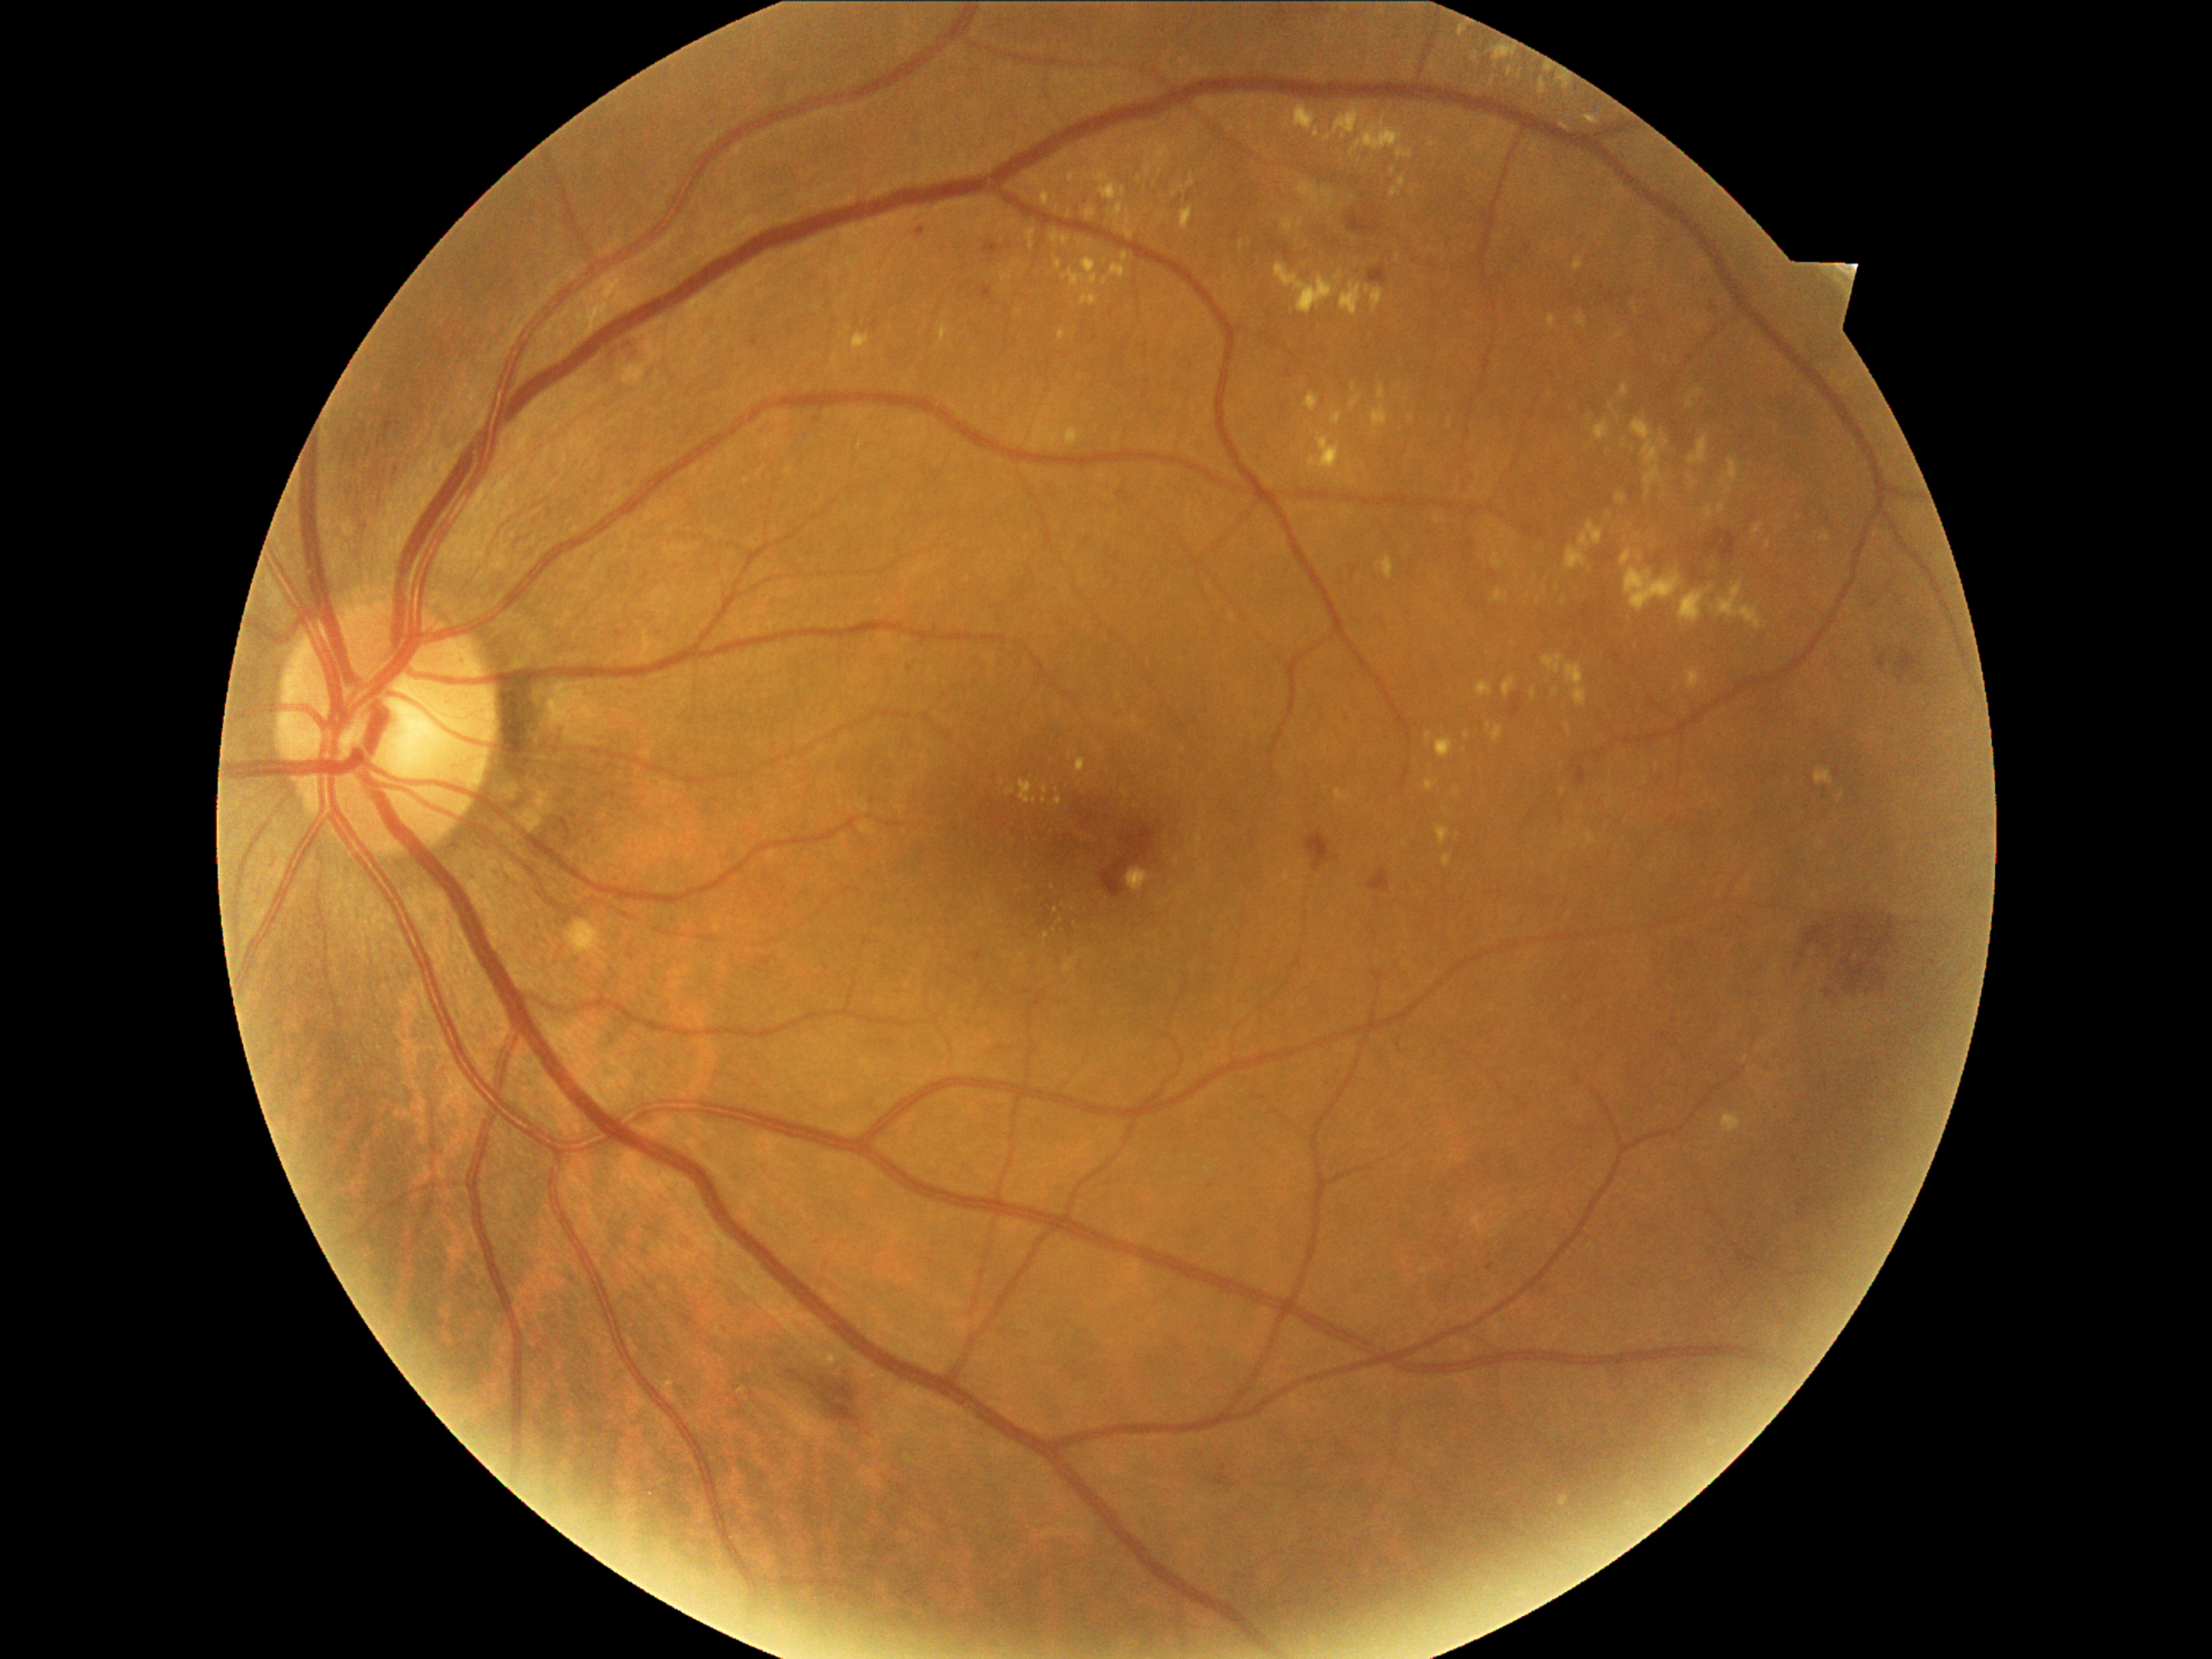 DR severity: 2. Disease class: non-proliferative diabetic retinopathy.